Modified Davis classification:
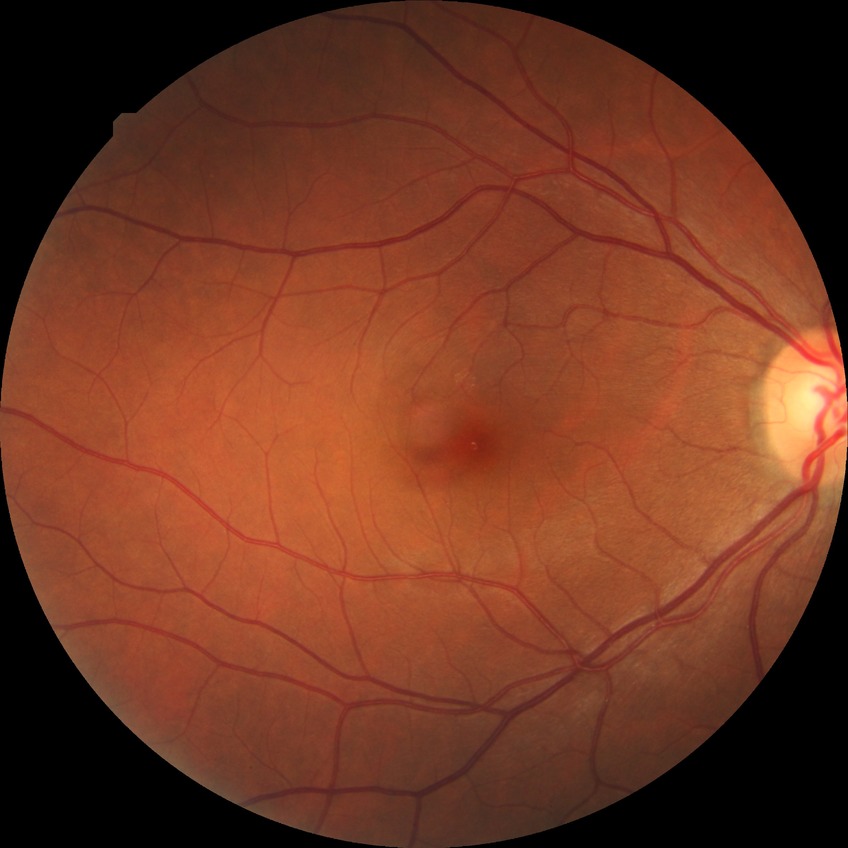

* modified Davis grading: no diabetic retinopathy